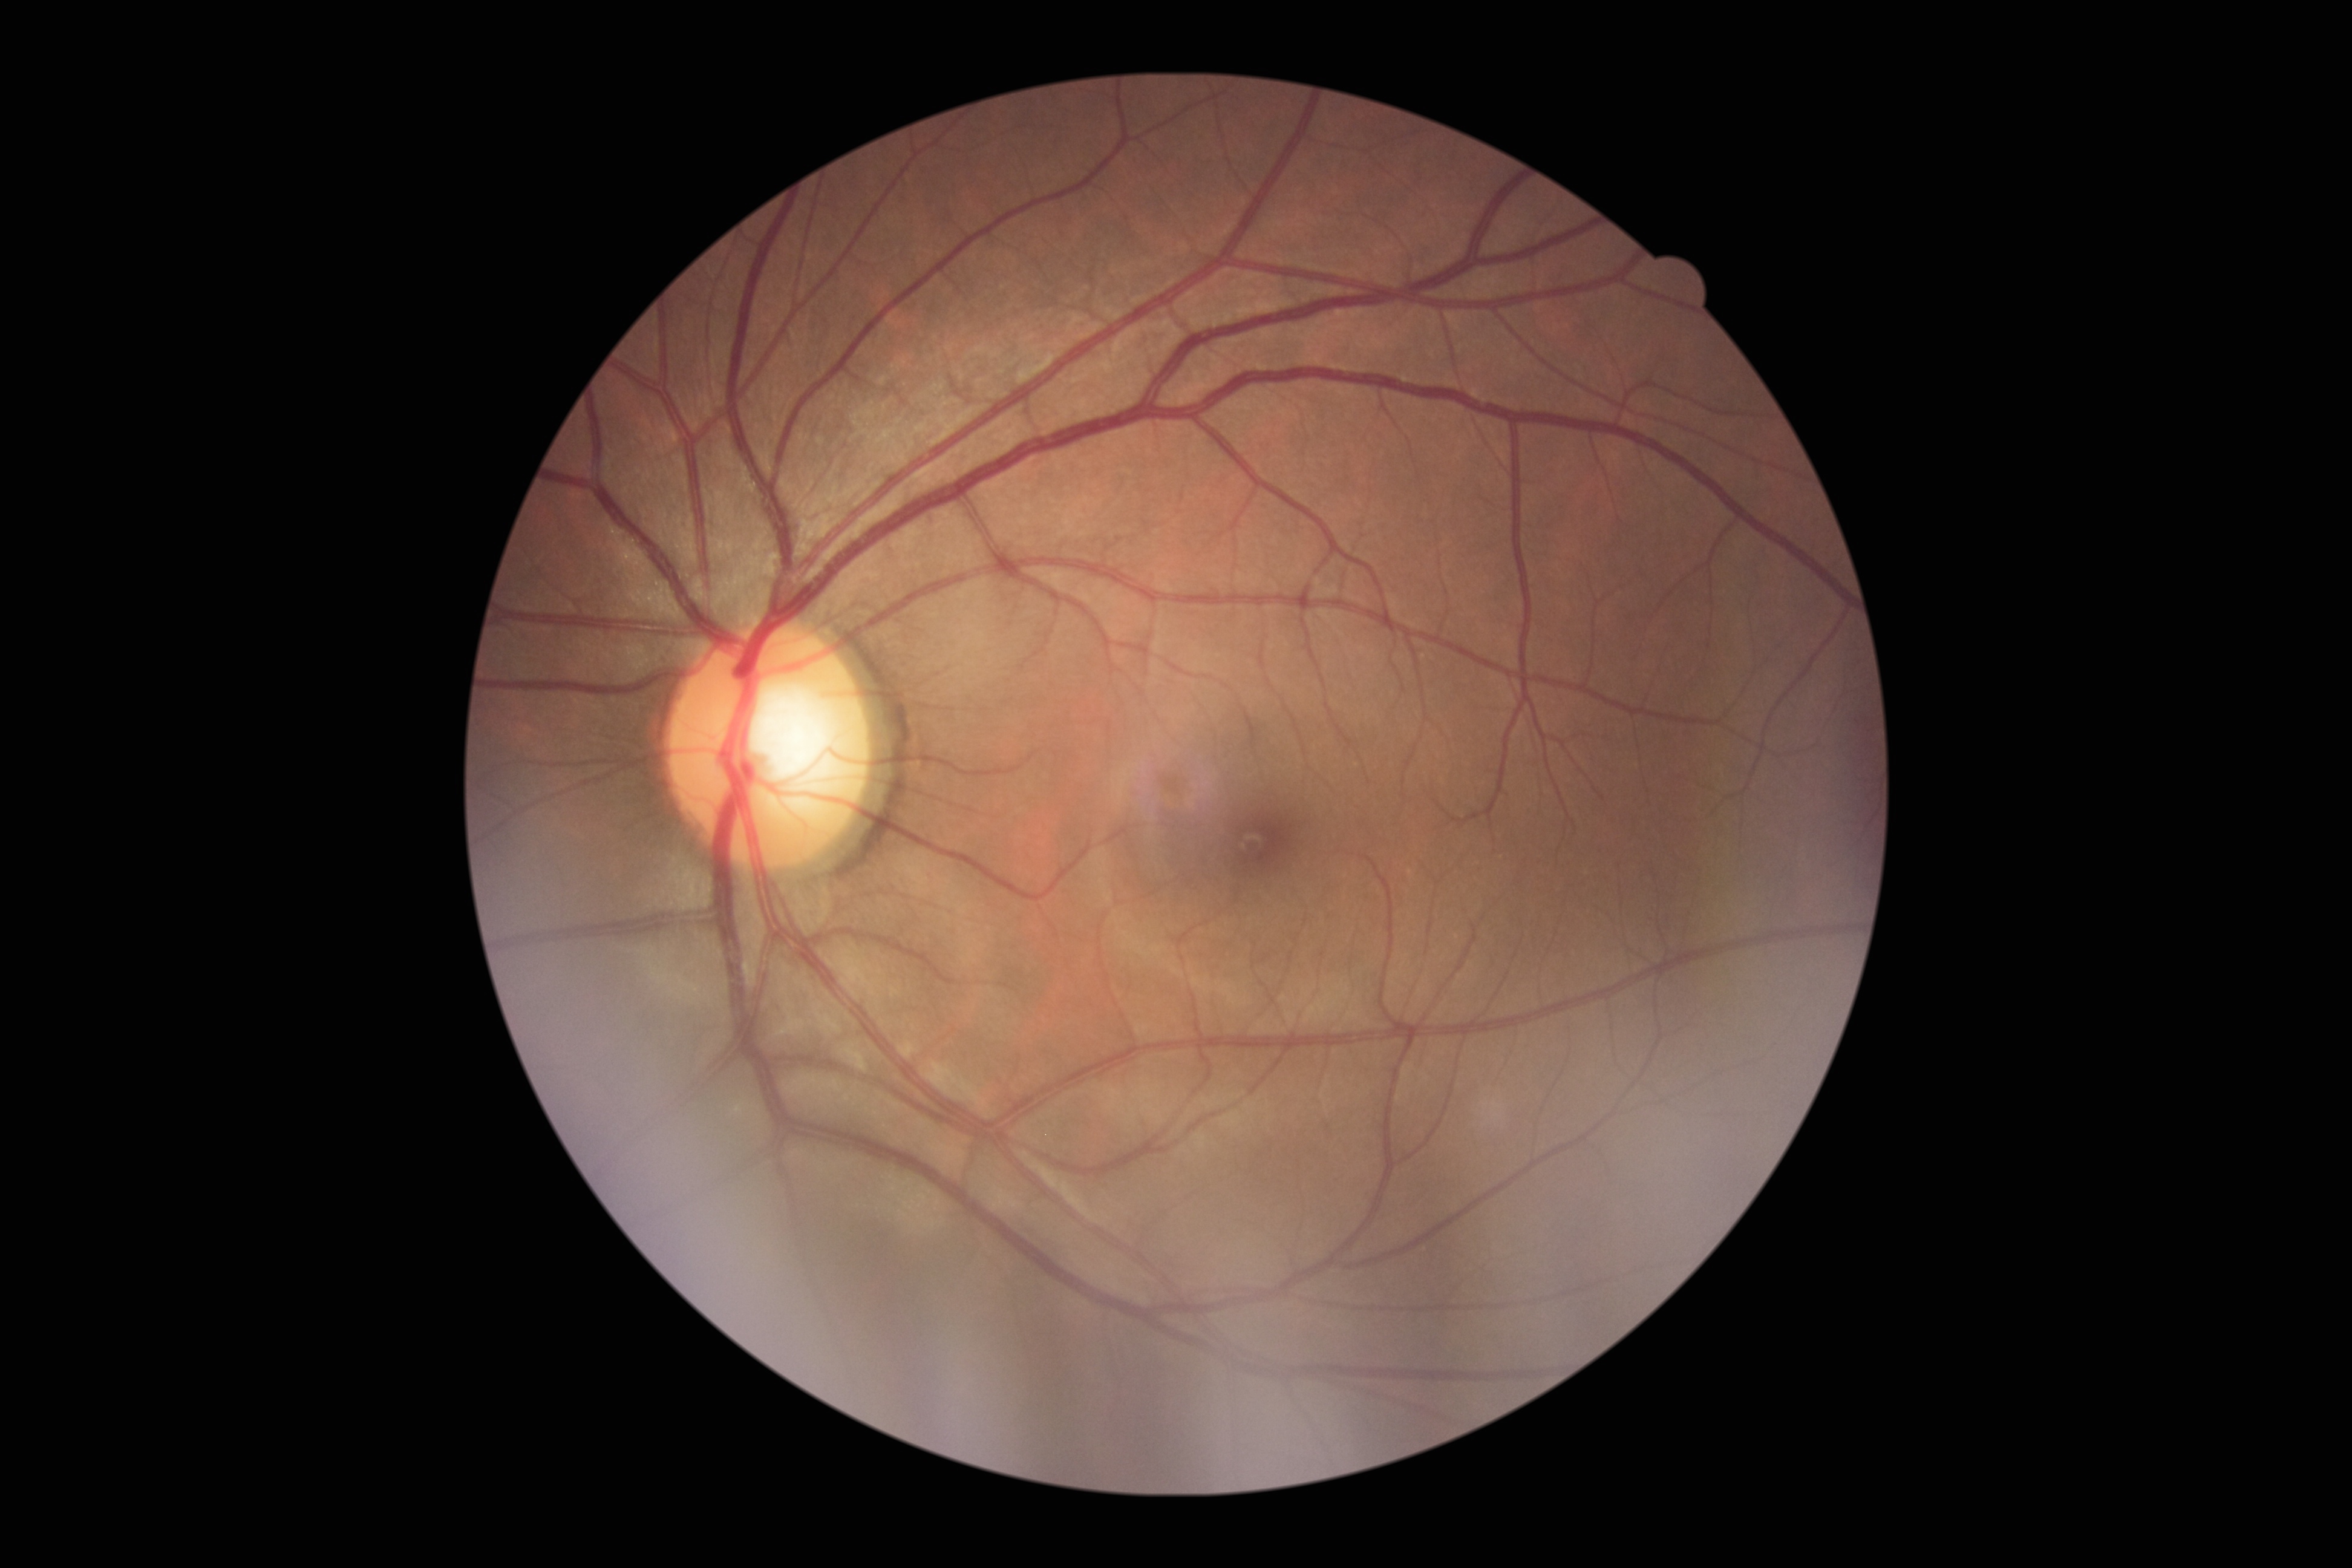
{
  "dr_grade": "0"
}